Fundus photo · 848 by 848 pixels · DR severity per modified Davis staging · 45° FOV · camera: NIDEK AFC-230 · without pupil dilation
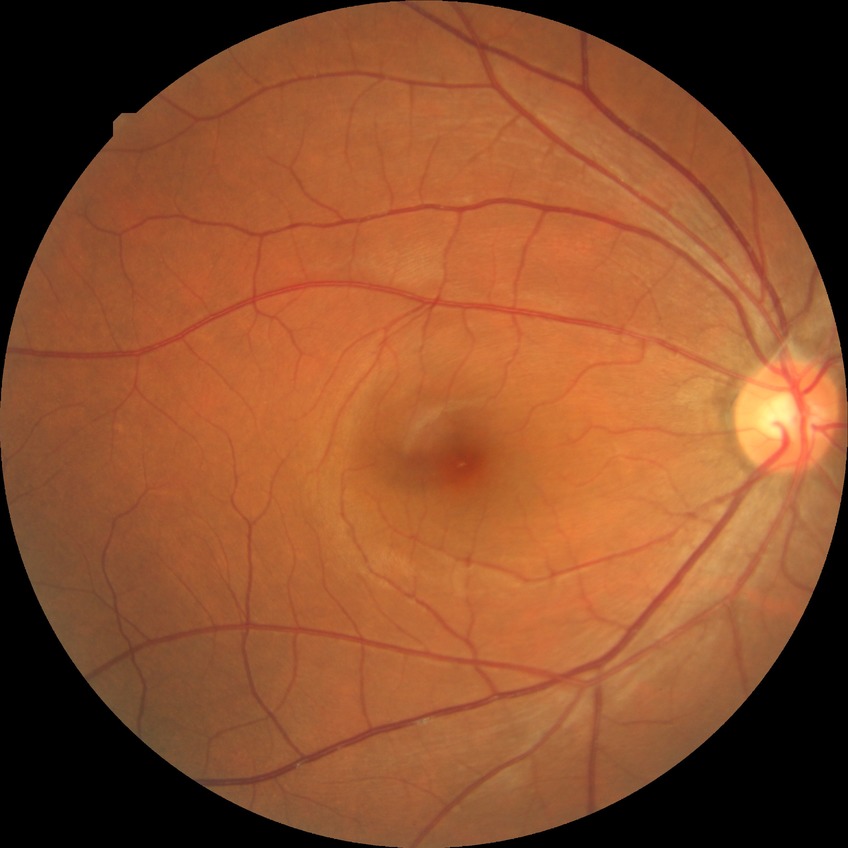
diabetic retinopathy (DR)=no diabetic retinopathy (NDR).